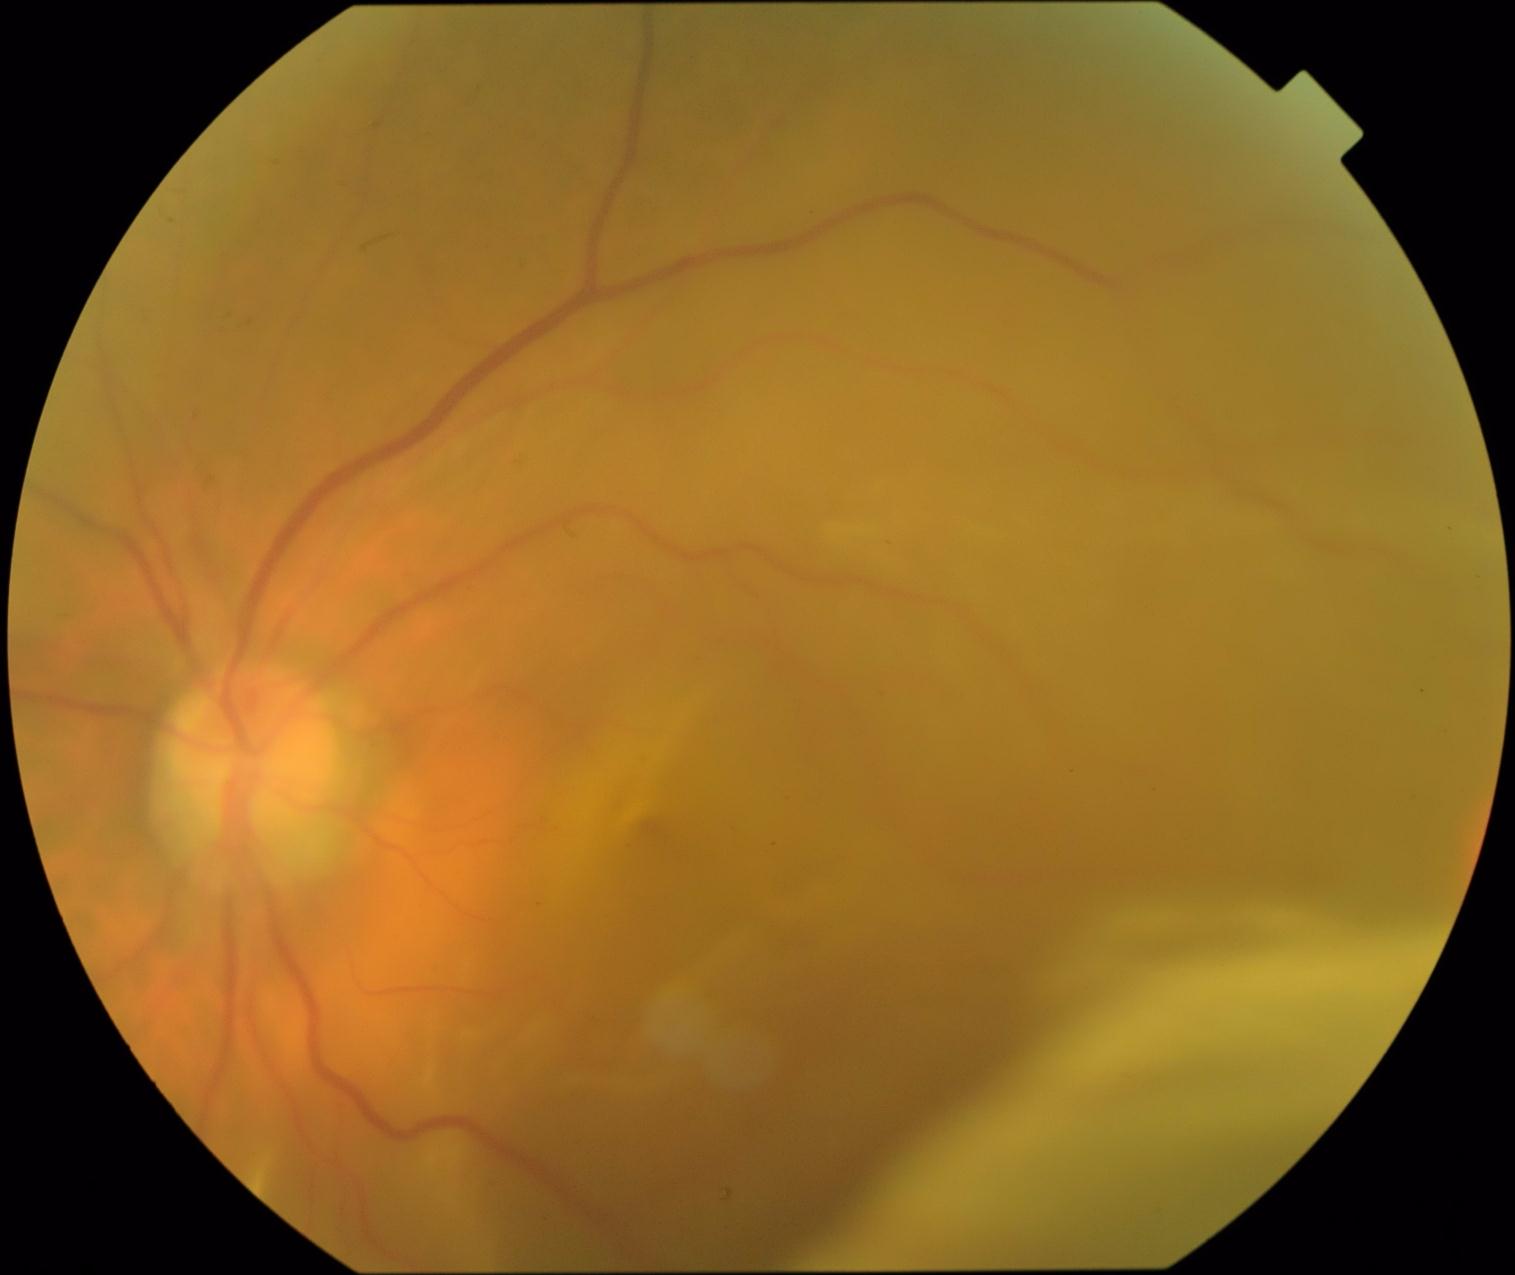
DR grade: 4.
The retinopathy is classified as proliferative diabetic retinopathy.